FOV: 45 degrees, 848x848, diabetic retinopathy graded by the modified Davis classification, NIDEK AFC-230 fundus camera, posterior pole photograph:
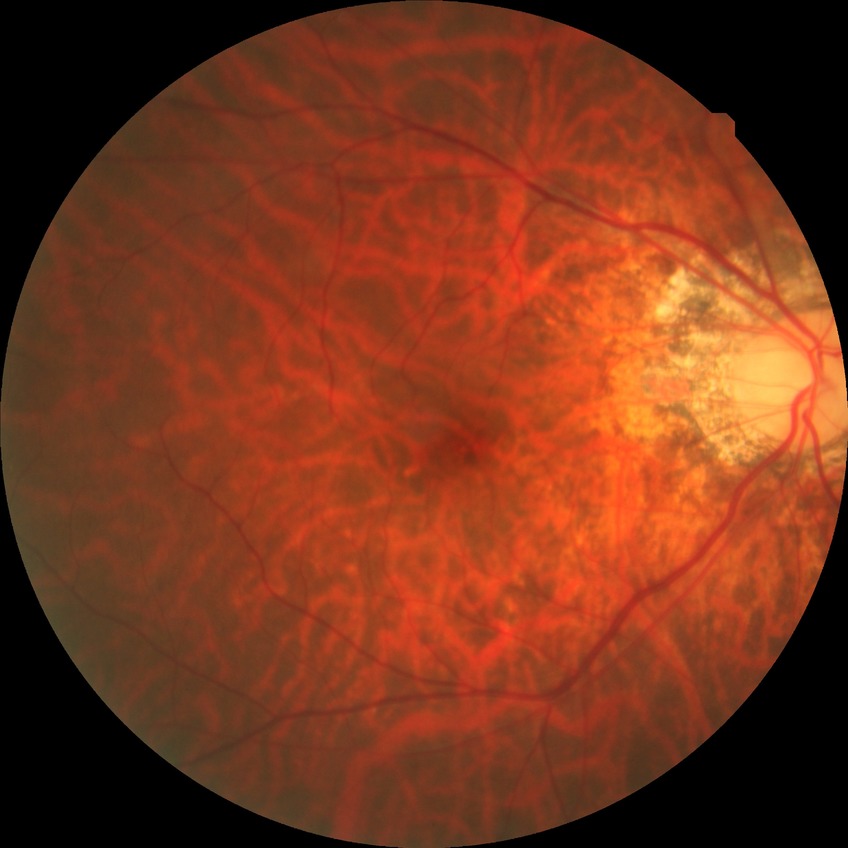

DR is NDR.